Graded on the modified Davis scale, 848 by 848 pixels, nonmydriatic fundus photograph, fundus photo: 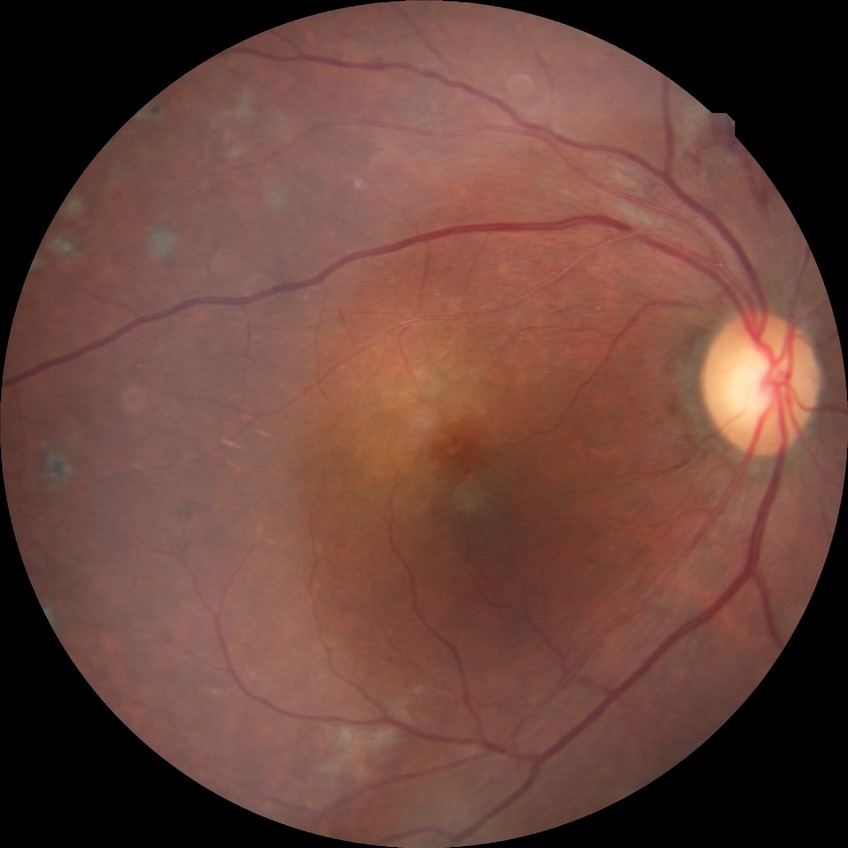

Diabetic retinopathy (DR): PDR (proliferative diabetic retinopathy).